No pharmacologic dilation, diabetic retinopathy graded by the modified Davis classification — 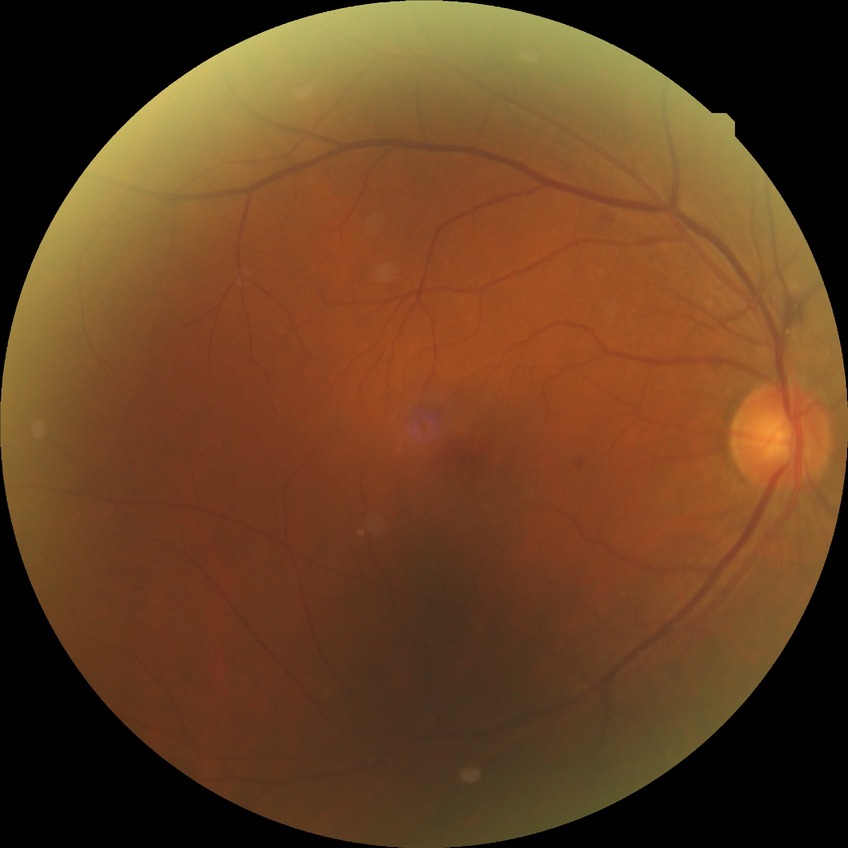

davis_grade: simple diabetic retinopathy (SDR)